2352x1568px · color fundus image — 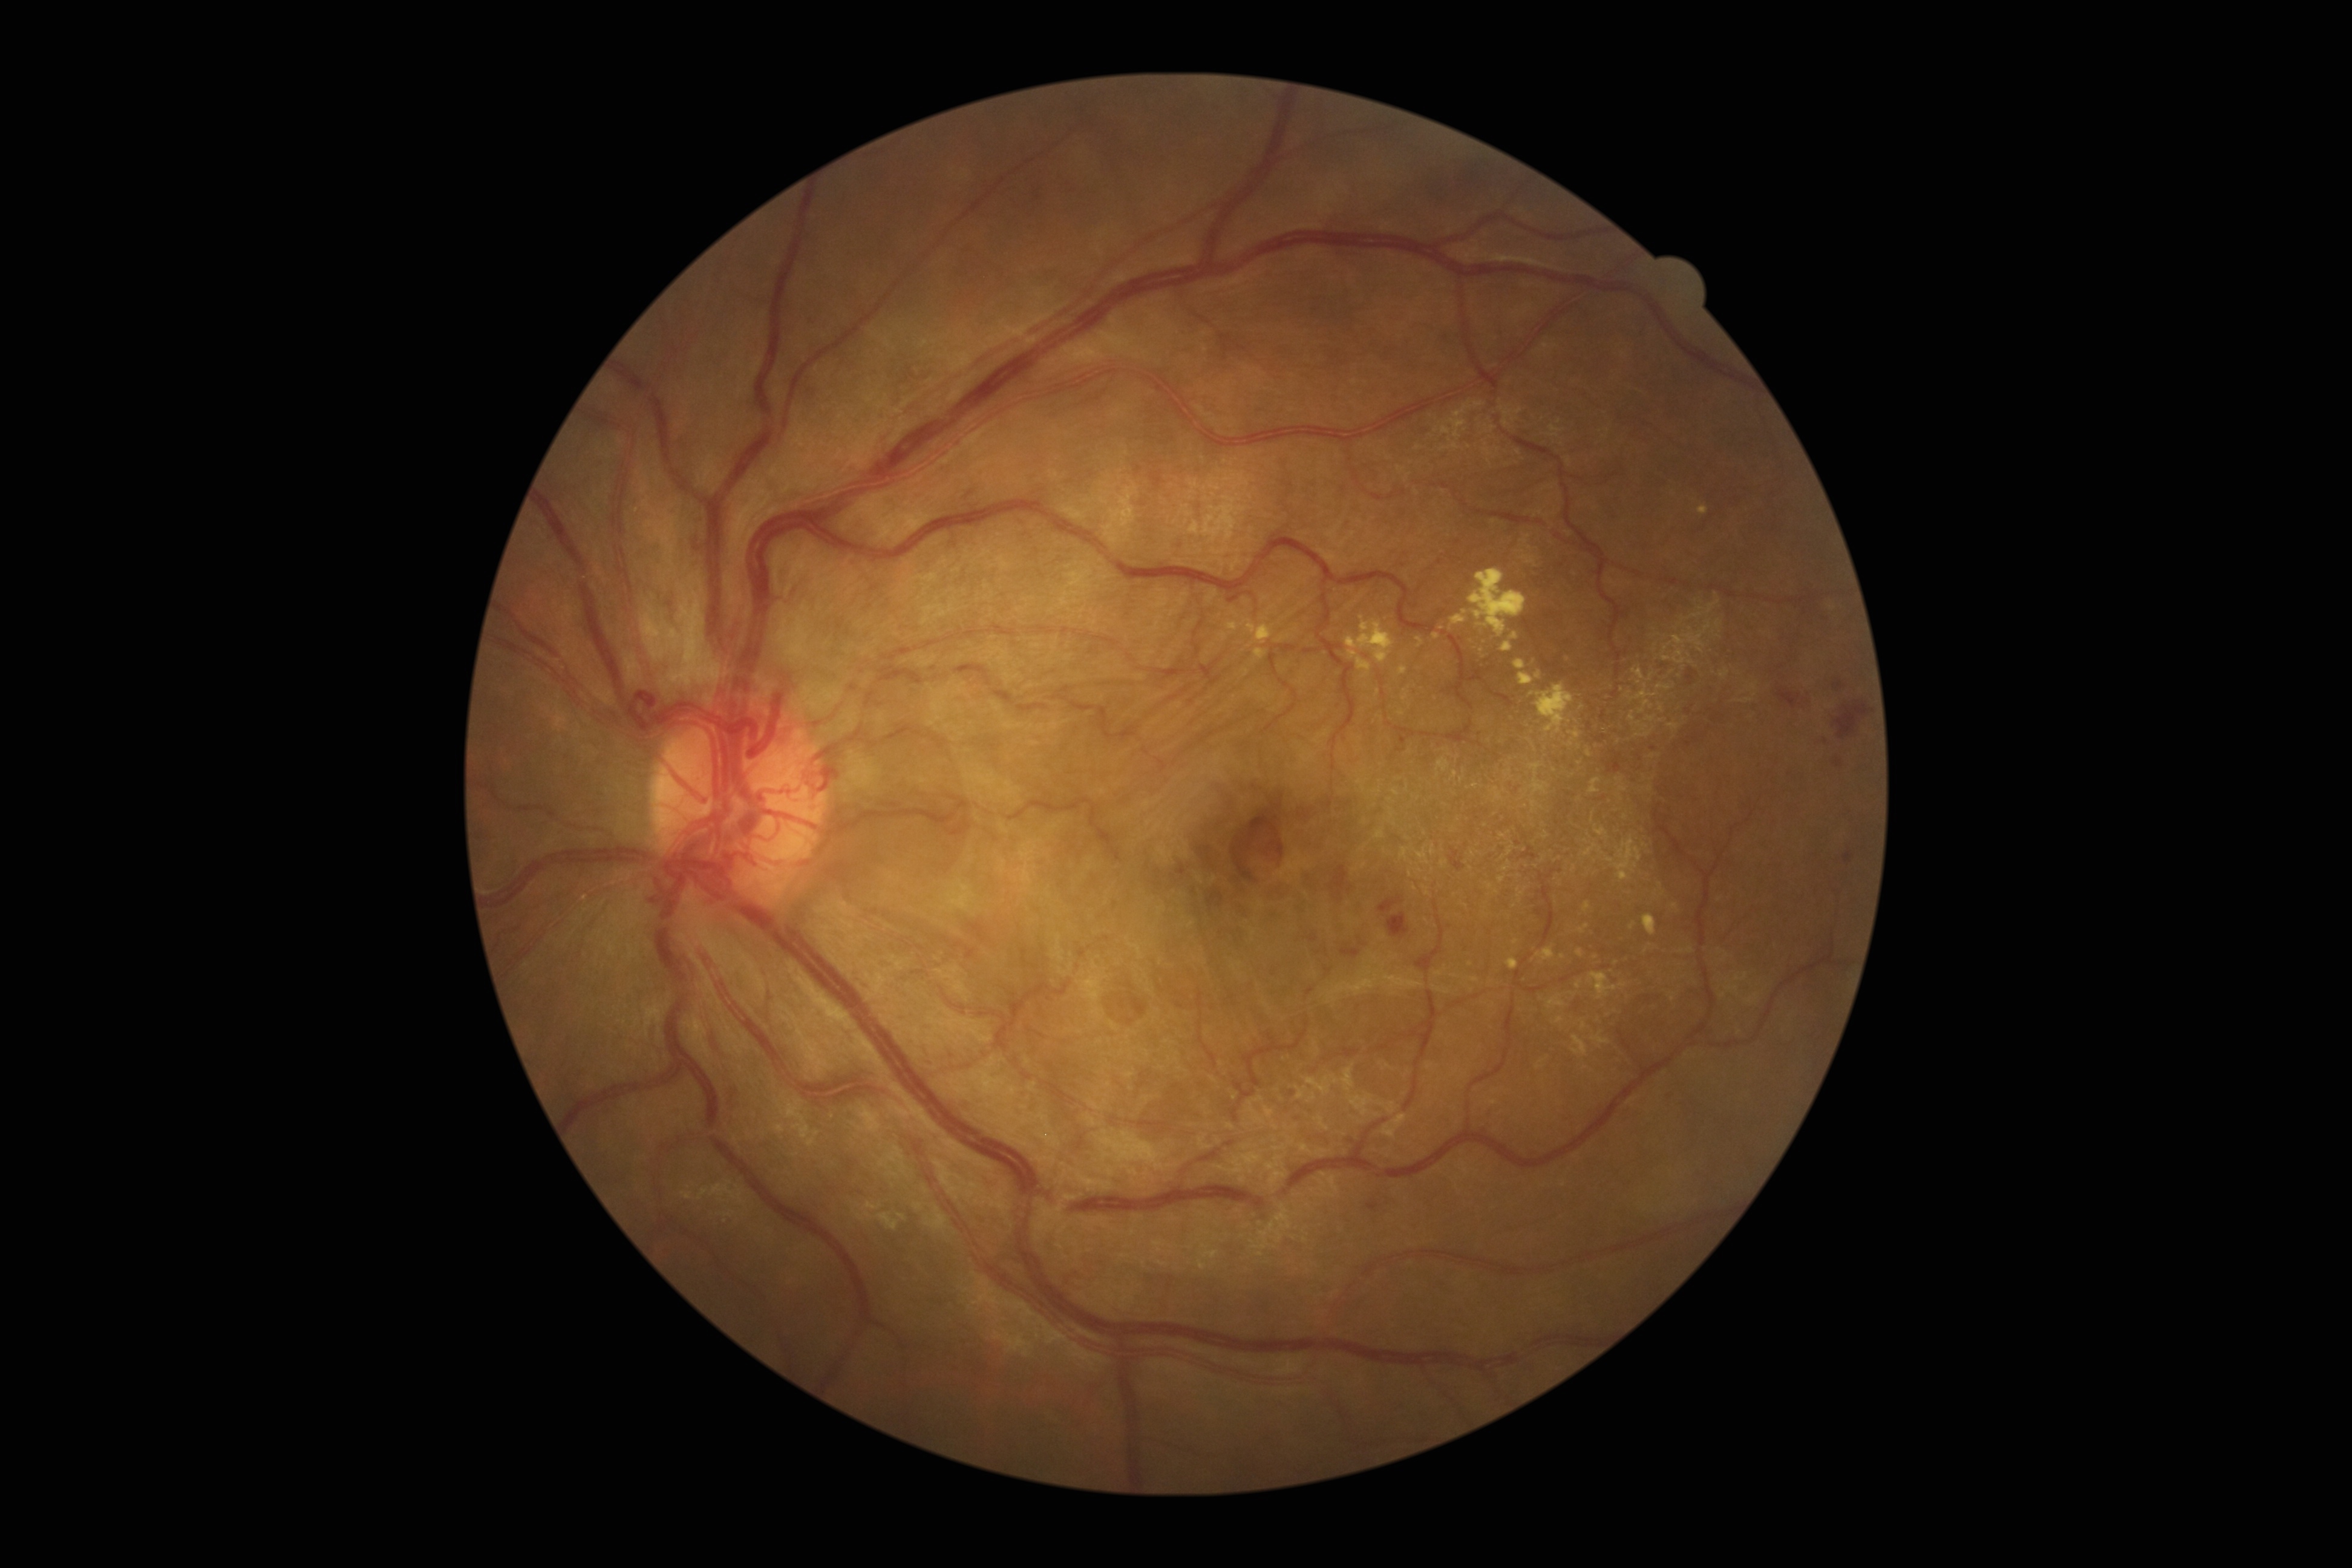 {"partial":true,"dr_grade":4,"lesions":{"ma":null,"ex":[[1468,569,1526,637],[1530,683,1575,735],[1514,659,1525,671],[1698,505,1709,516],[1502,643,1513,653],[1537,946,1555,961],[1535,672,1542,681],[1576,981,1582,989],[1588,972,1617,999],[1583,902,1590,913],[1399,666,1409,676],[1616,871,1632,881],[1451,615,1467,625],[1467,977,1479,982]],"ex_small":[[1624,985],[1471,964],[1581,707],[1568,658],[1515,636],[1429,657]],"he":[[1379,896,1403,913],[958,481,987,501],[1387,913,1410,938],[1687,668,1693,684],[1310,933,1318,943],[1835,701,1870,740],[1834,759,1843,768],[1616,607,1629,622],[1778,689,1801,710],[1367,1201,1379,1213],[1834,682,1844,690],[1449,848,1466,871],[1844,851,1854,862],[1330,866,1354,903],[1340,944,1361,958]],"he_small":[[1292,1094],[1654,748],[1688,744]],"se":null}}